Image size 2352x1568.
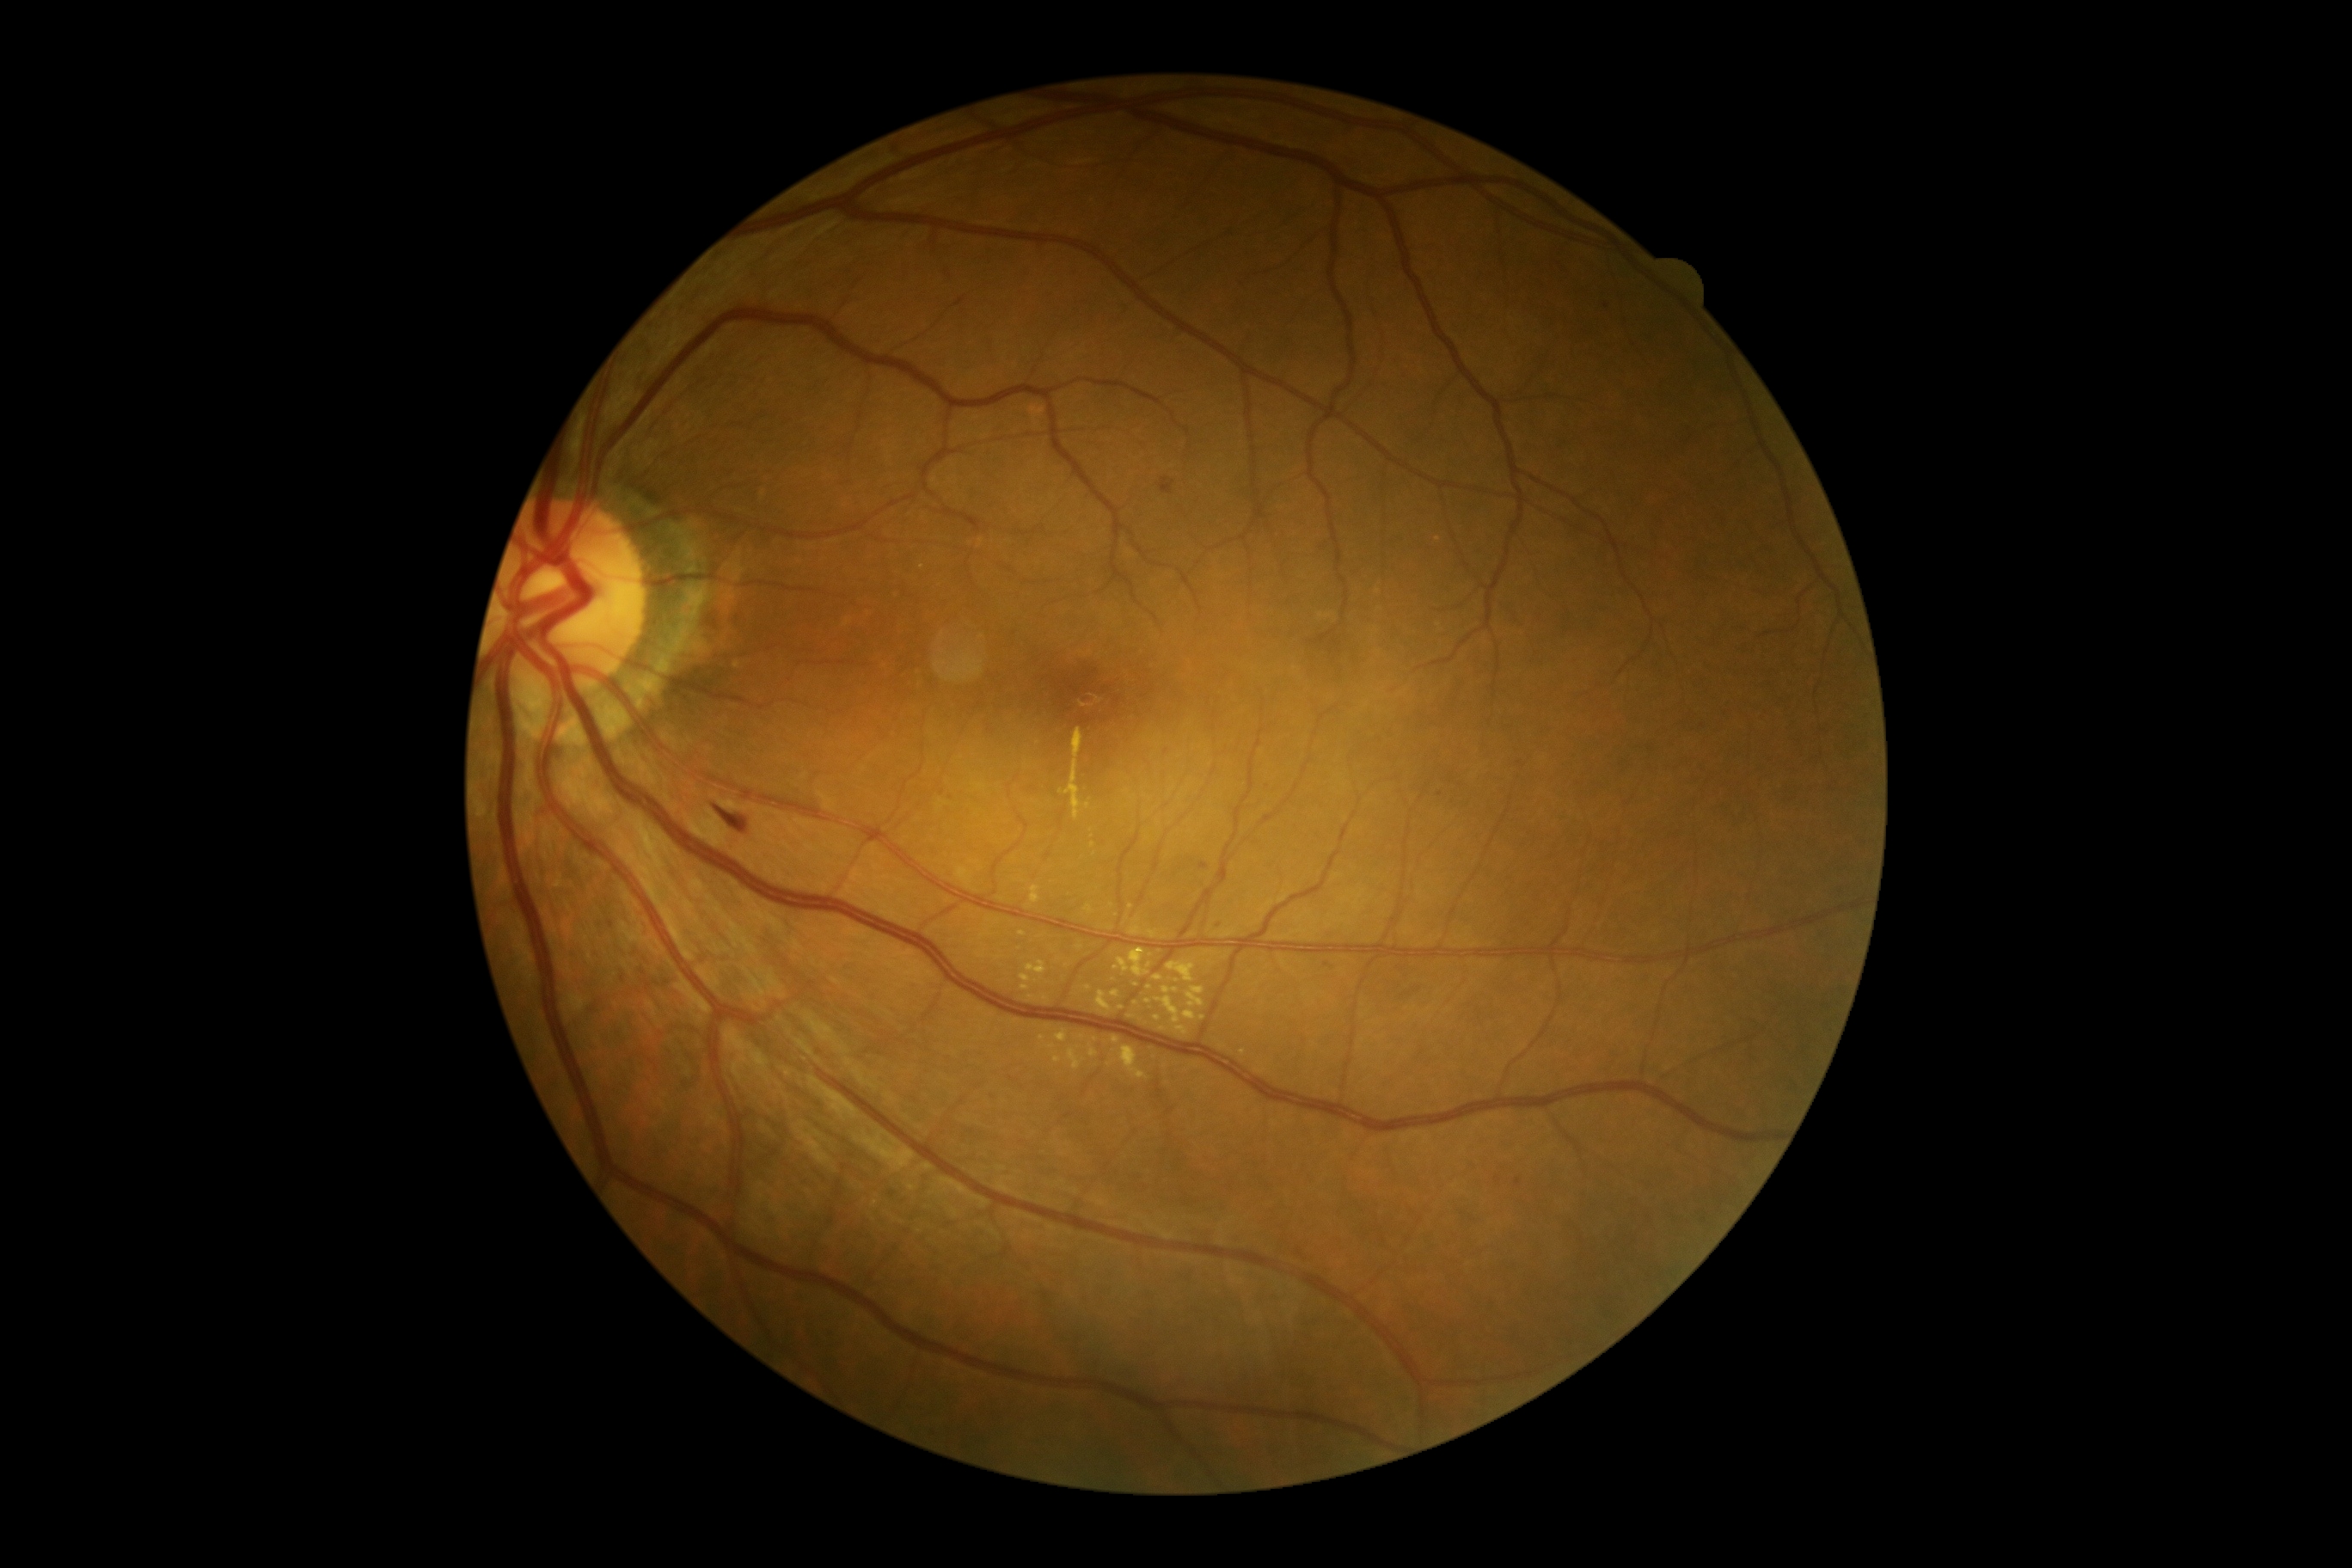 Retinopathy grade: 2. Microaneurysms identified at region(1516, 1179, 1521, 1187) | region(1199, 864, 1210, 869). Small microaneurysms approximately at x=1605 y=307 | x=1499 y=1179 | x=1327 y=964 | x=1440 y=795 | x=943 y=793. Hard exudates include region(1177, 1027, 1189, 1036) | region(1098, 991, 1112, 1012) | region(1167, 962, 1196, 984) | region(1065, 1046, 1086, 1072) | region(1089, 1044, 1098, 1058) | region(1060, 728, 1084, 821) | region(1031, 886, 1041, 903). Small hard exudates approximately at x=1137 y=986 | x=1096 y=1039 | x=1020 y=950 | x=1022 y=935 | x=1110 y=928 | x=1158 y=1018 | x=1150 y=966 | x=1115 y=1041. Hemorrhages identified at region(1160, 479, 1175, 494) | region(709, 799, 749, 831). No soft exudates identified.